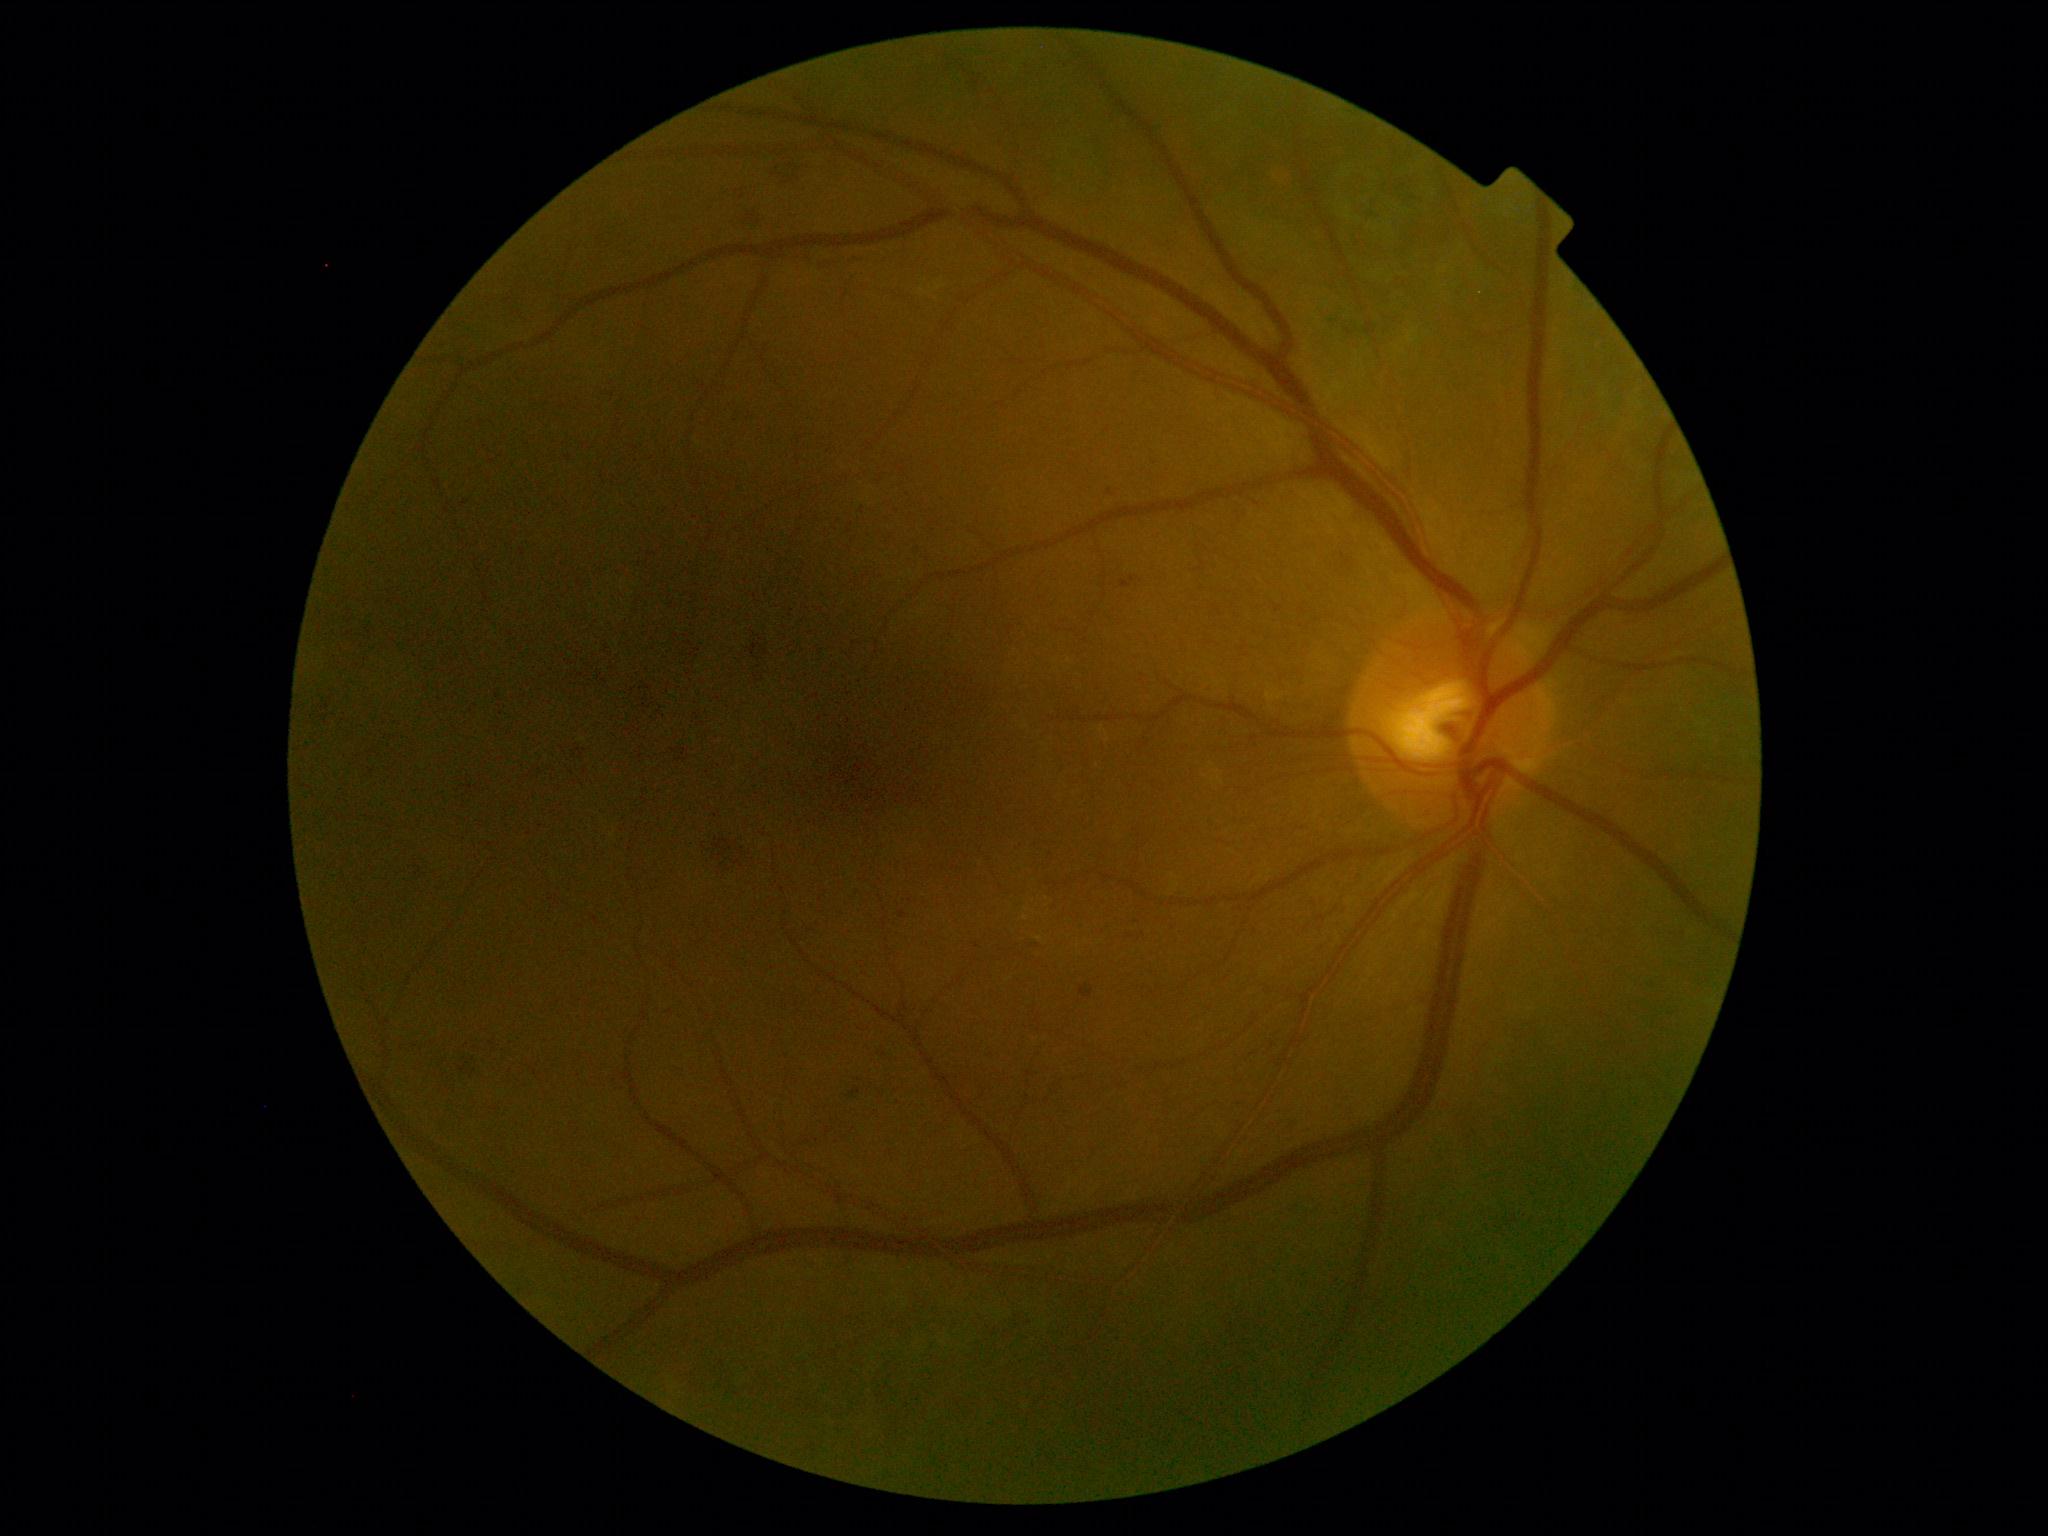
DR severity: 2.